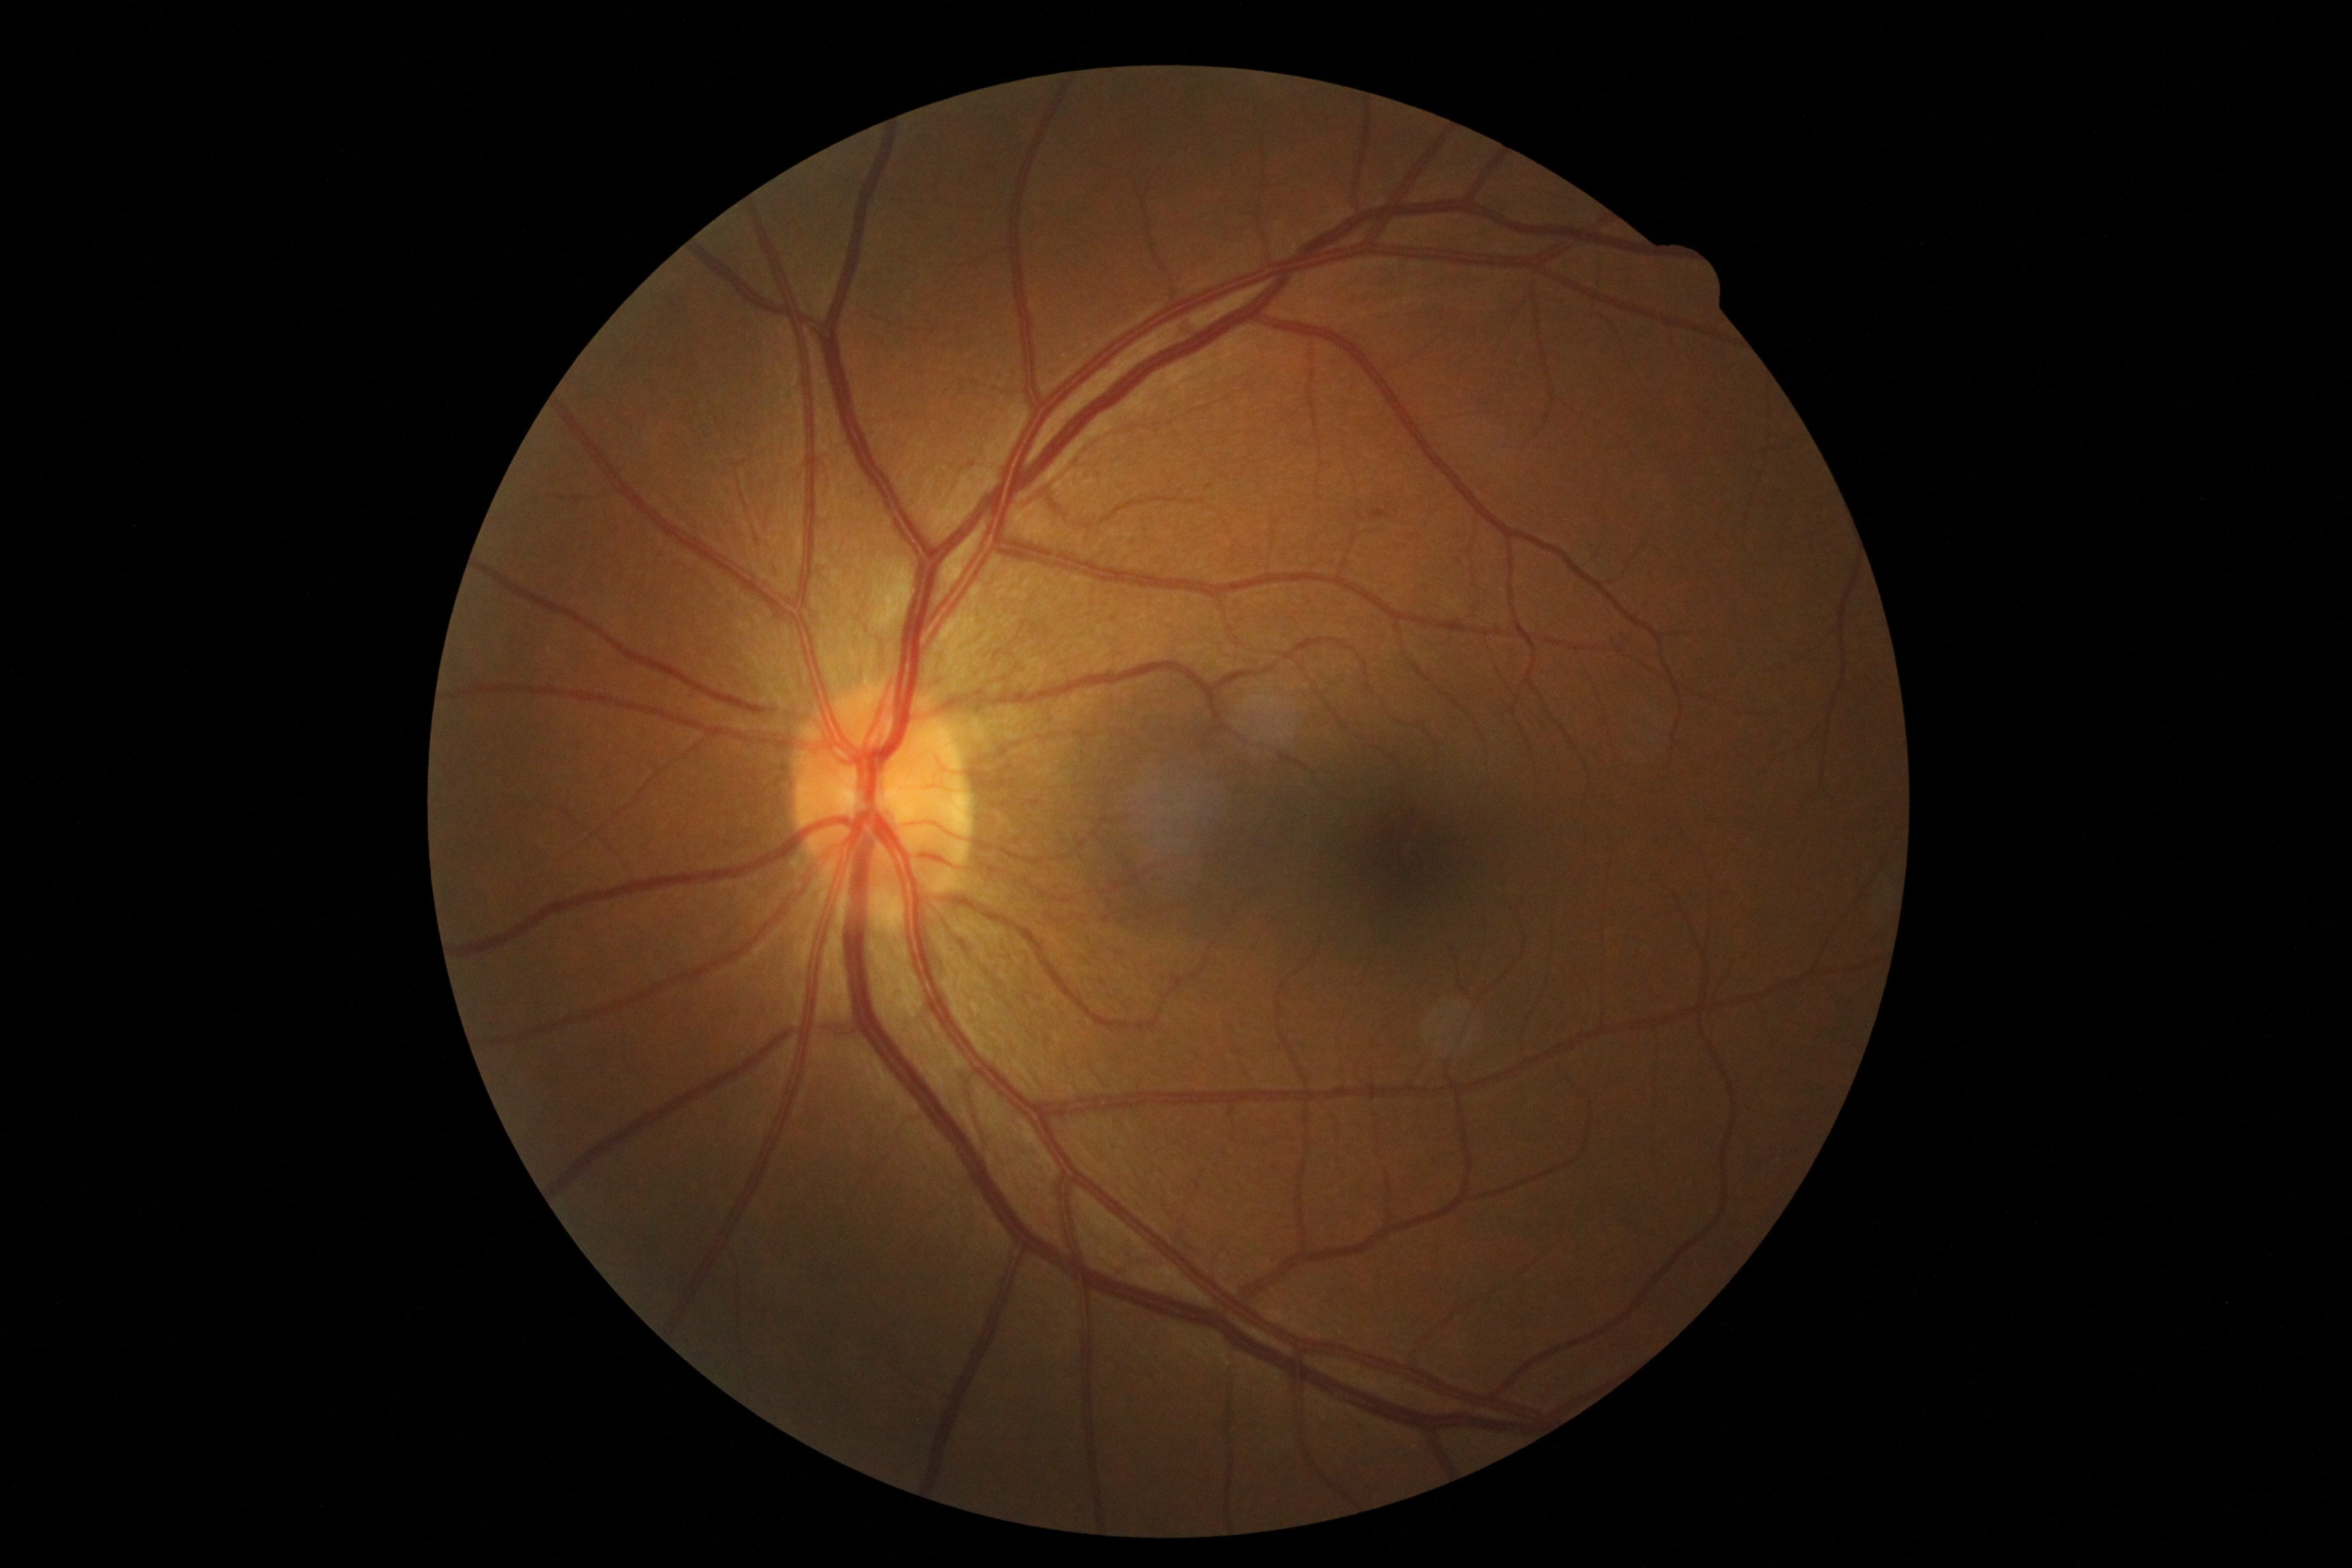 DR class: non-proliferative diabetic retinopathy, DR severity: grade 1 (mild NPDR).